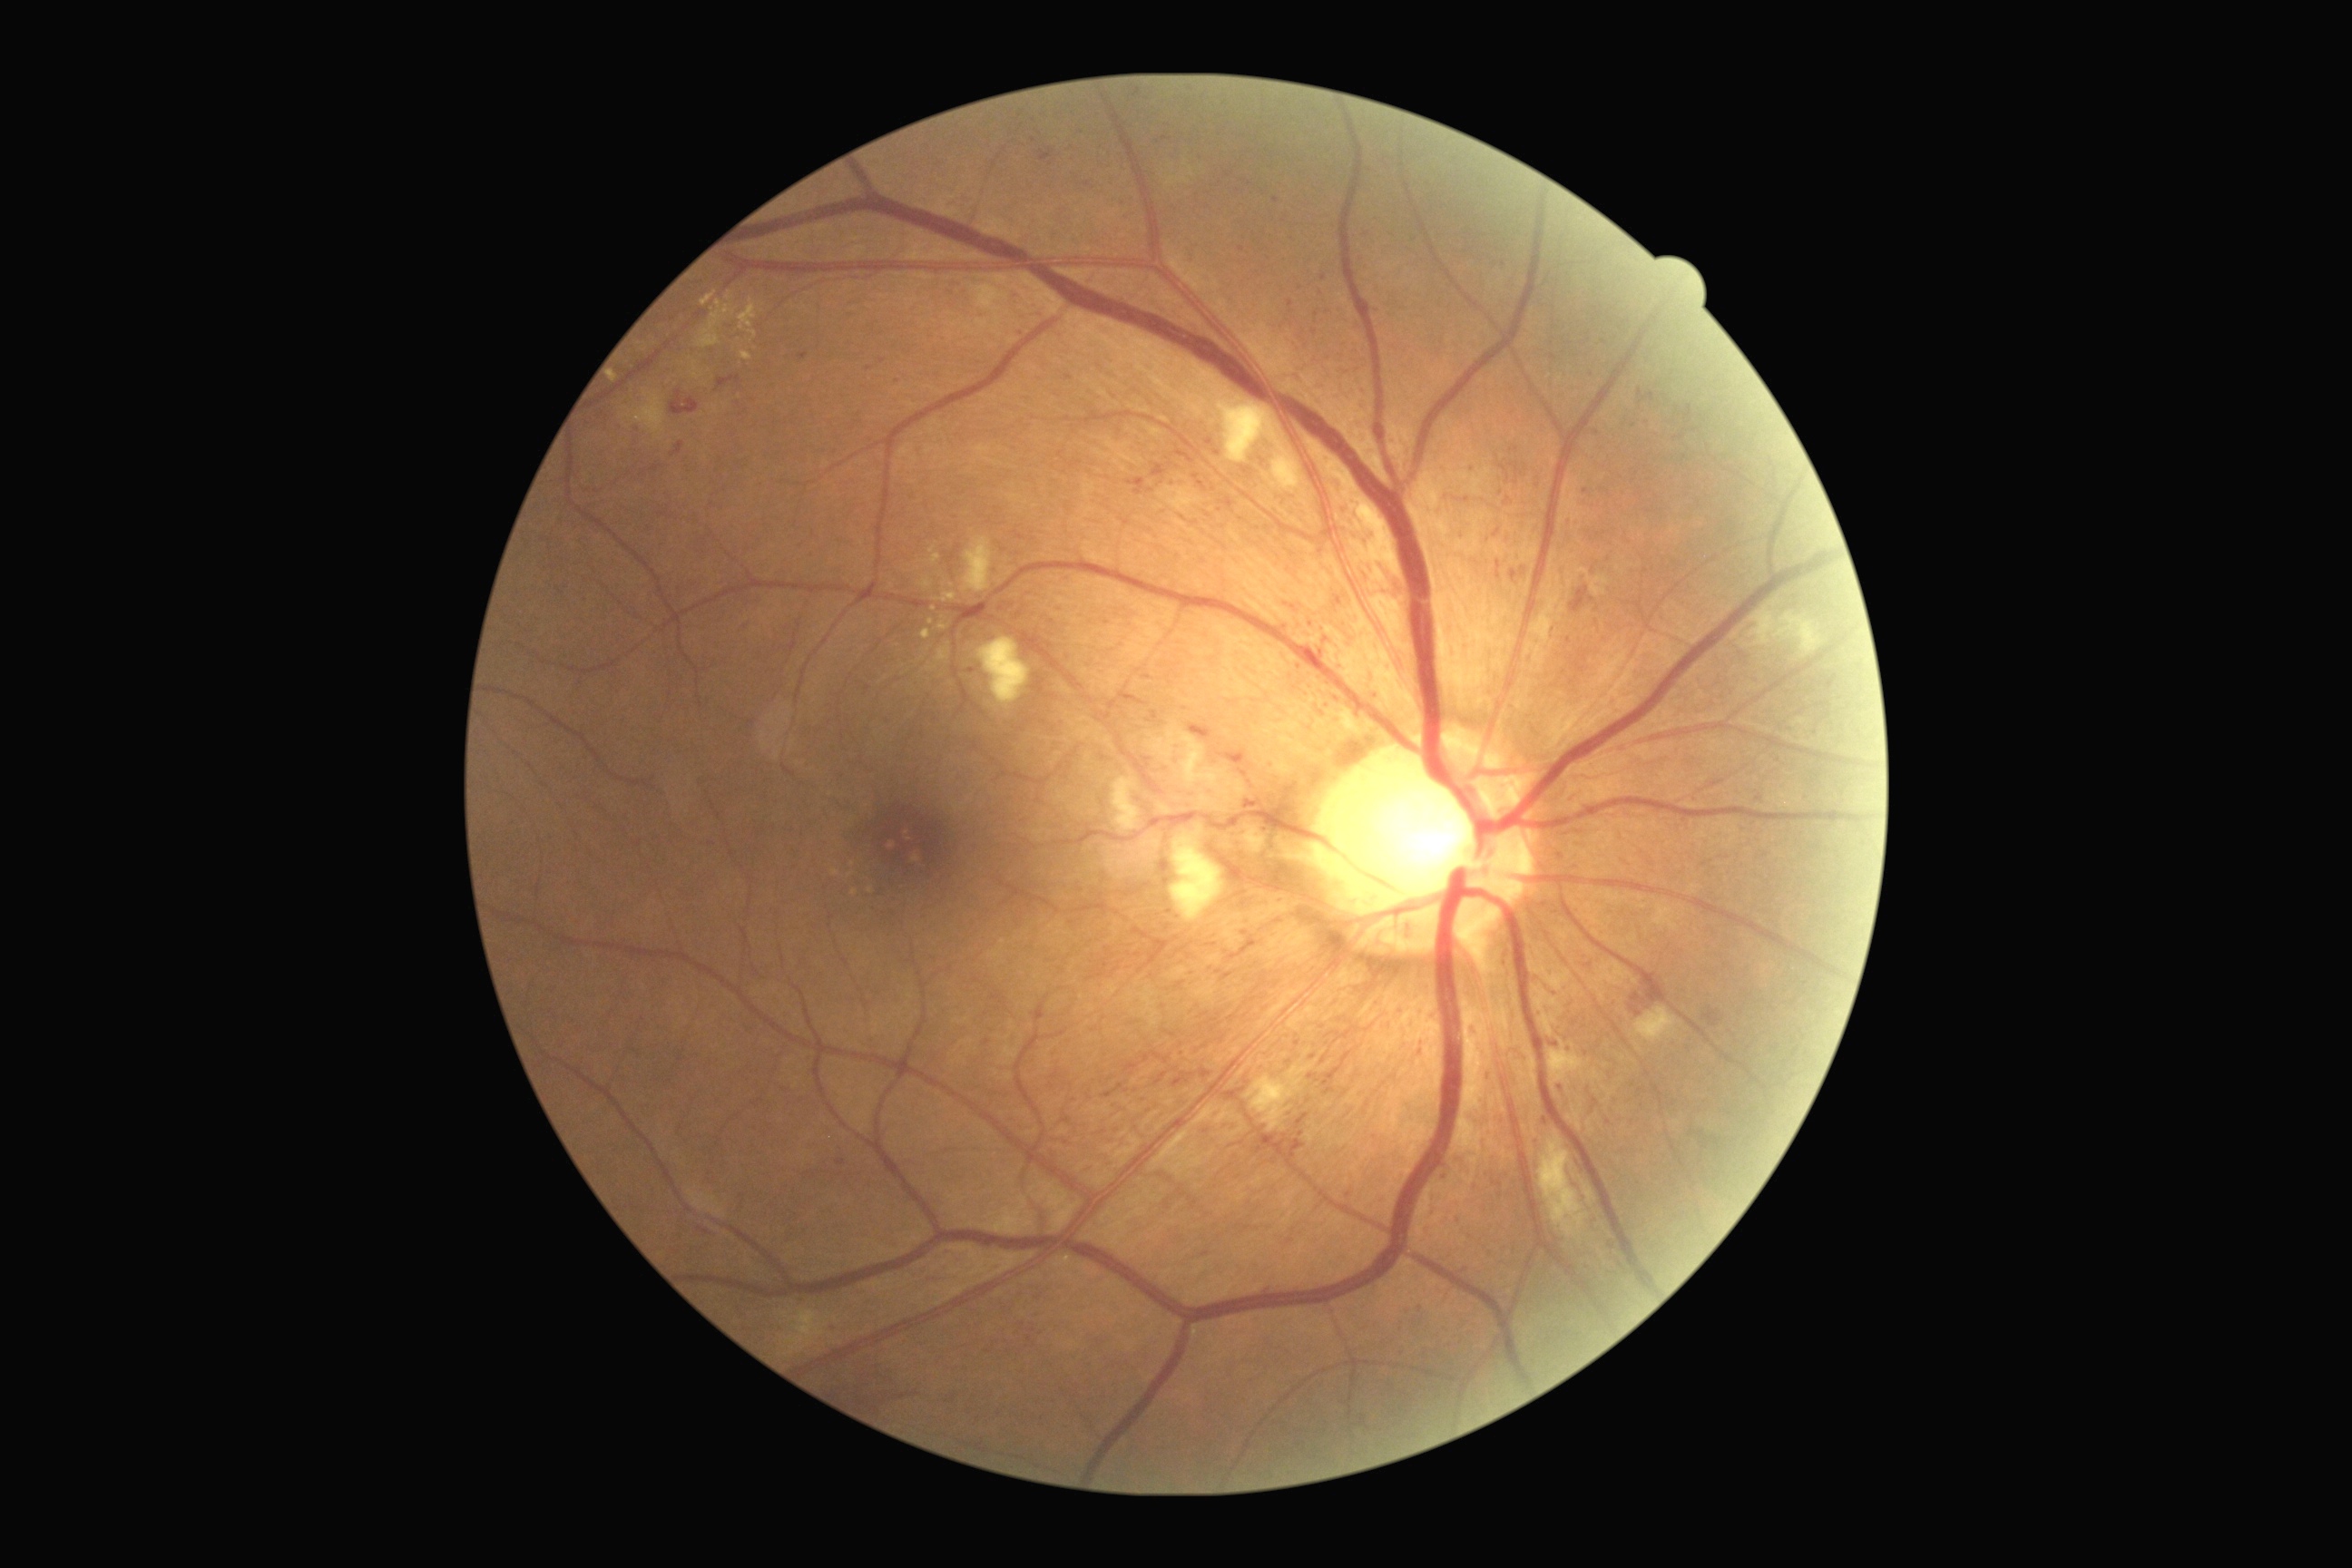 The retinopathy is classified as non-proliferative diabetic retinopathy.
DR stage is 2/4.